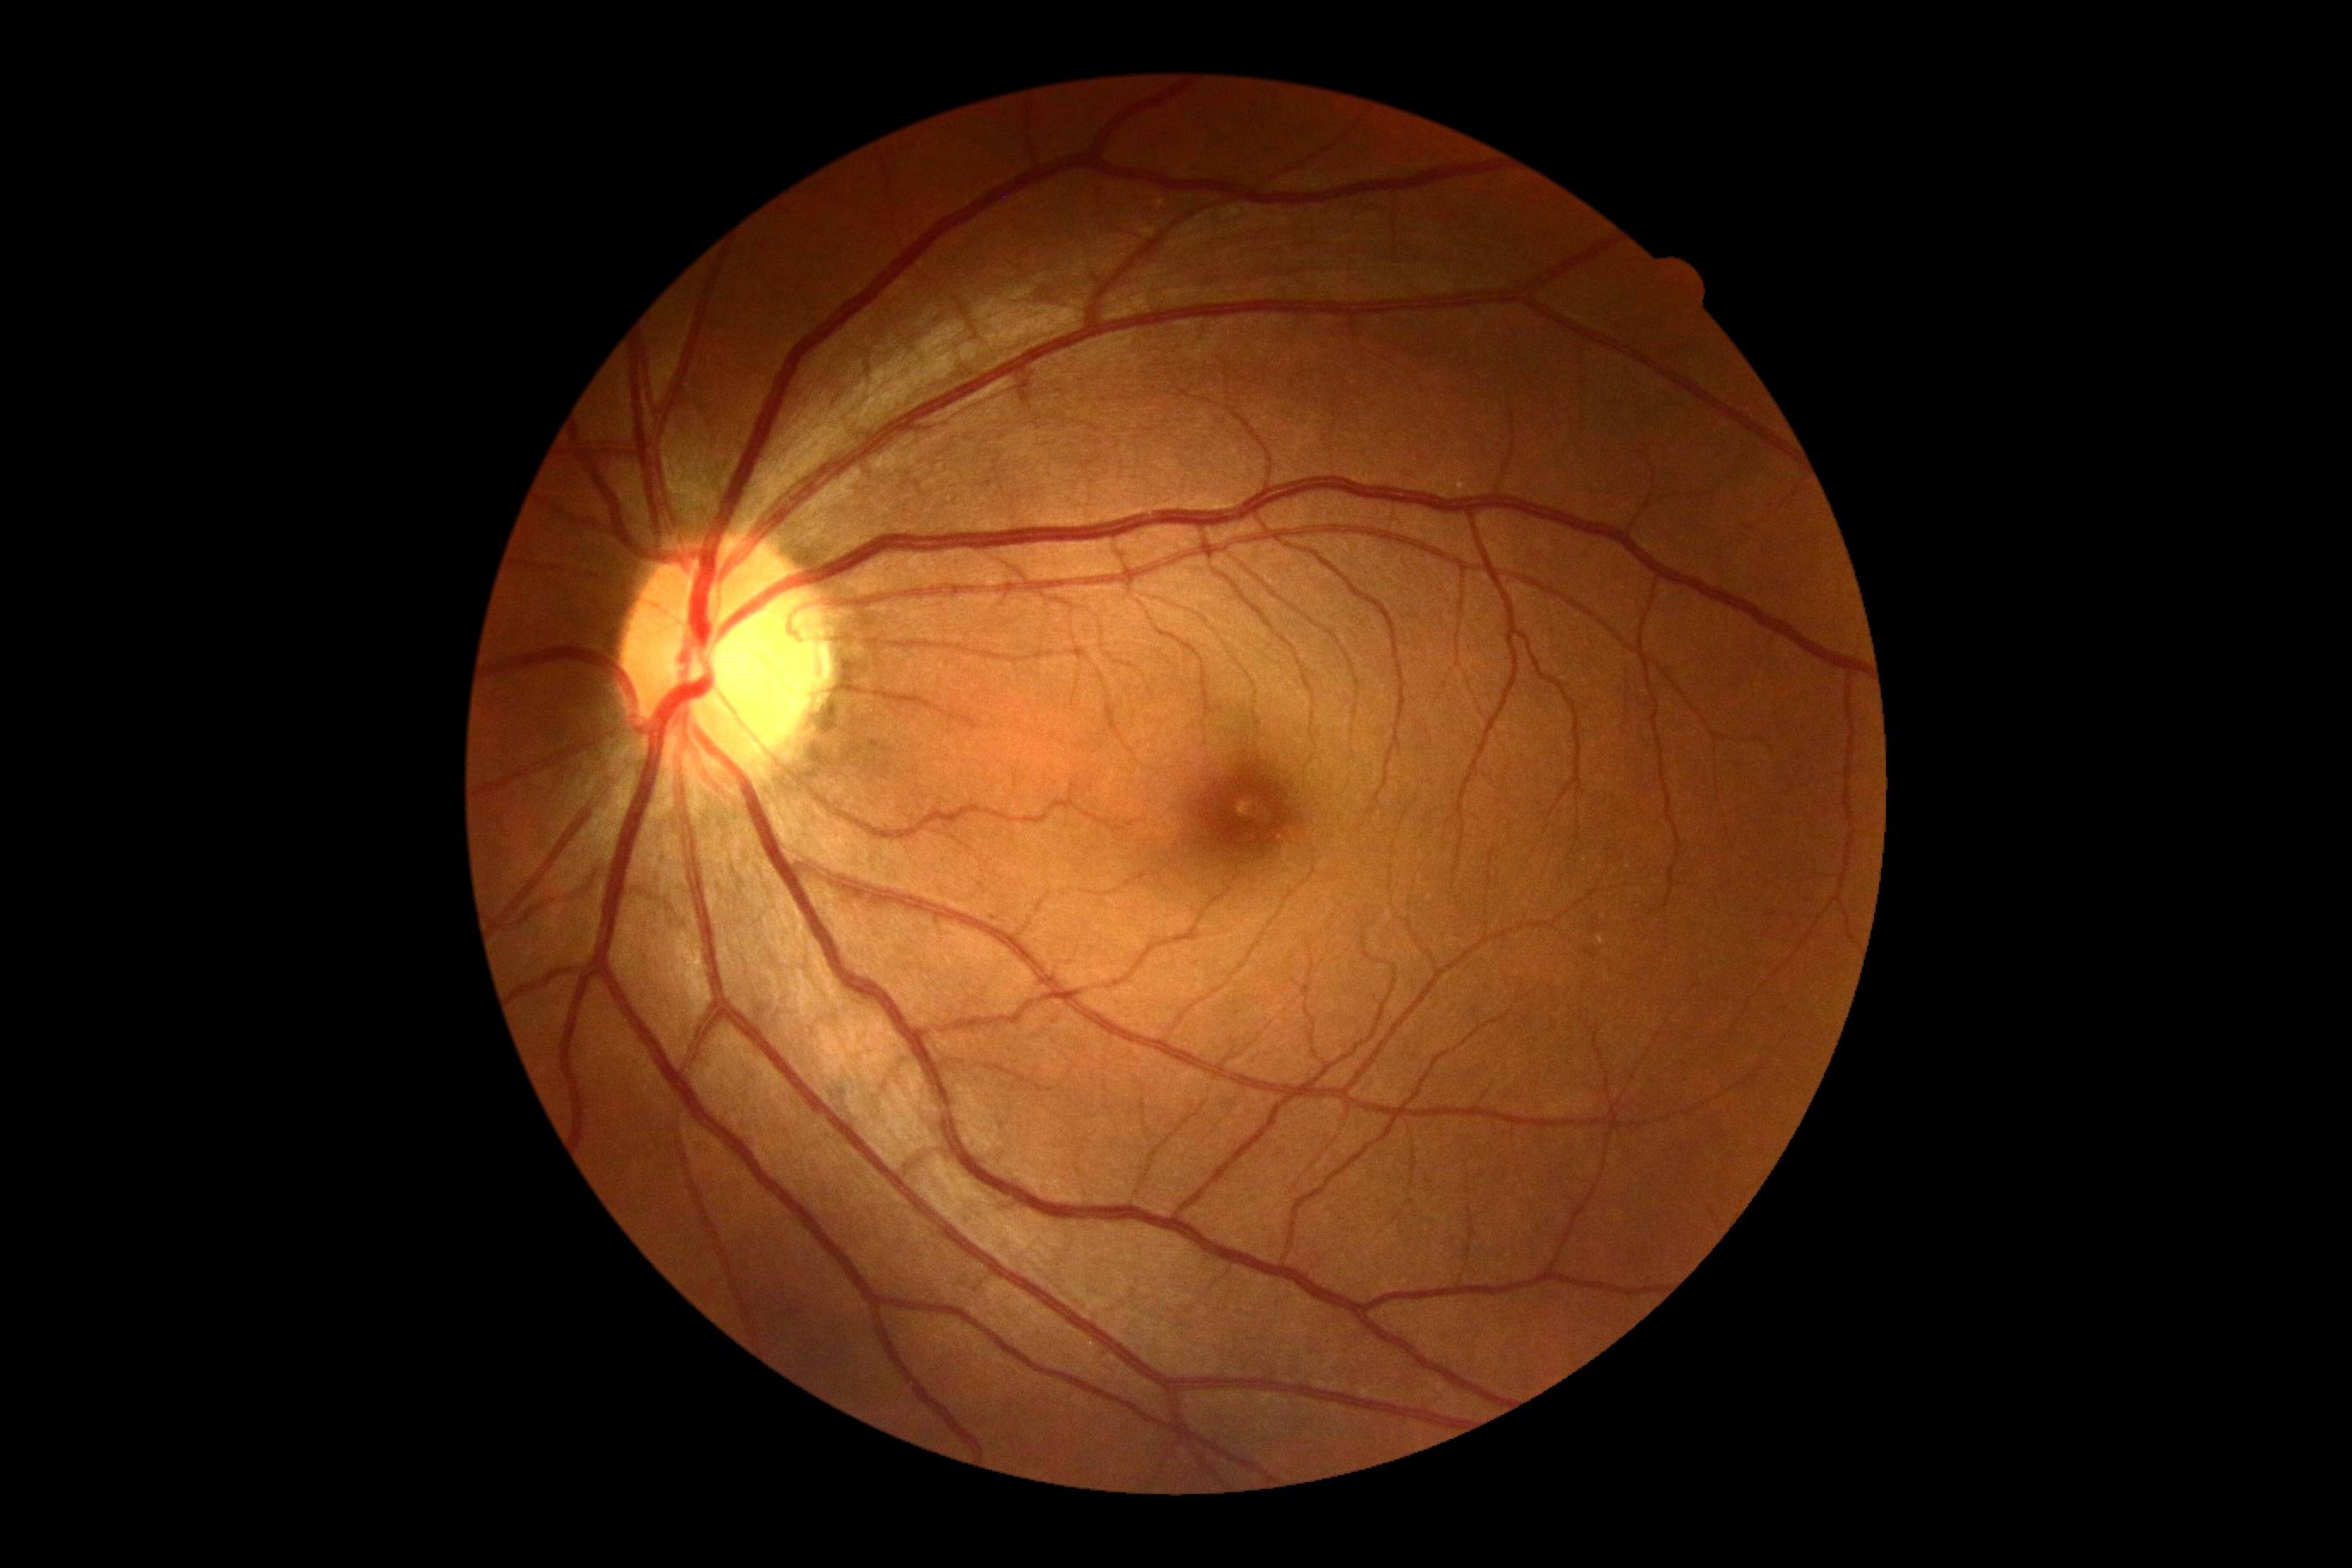 DR severity is no apparent retinopathy (grade 0).